Infant wide-field retinal image — 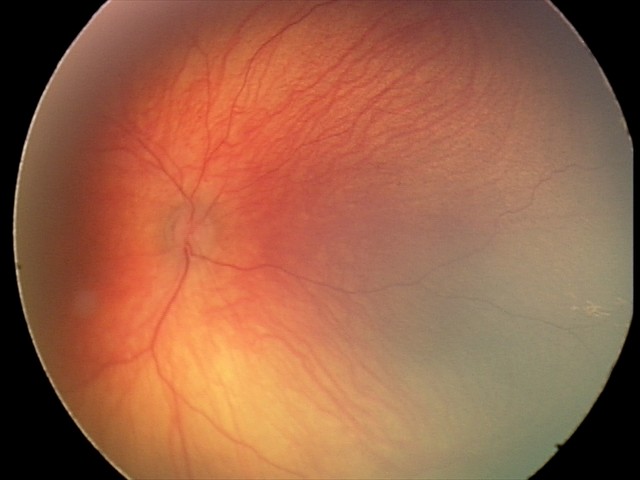 Q: What is the screening diagnosis?
A: physiological appearance with no retinal pathology